RetCam wide-field infant fundus image.
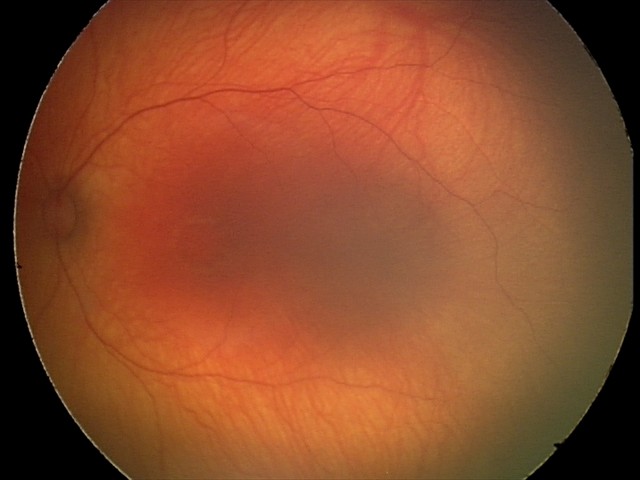

Screening examination with no abnormal retinal findings.